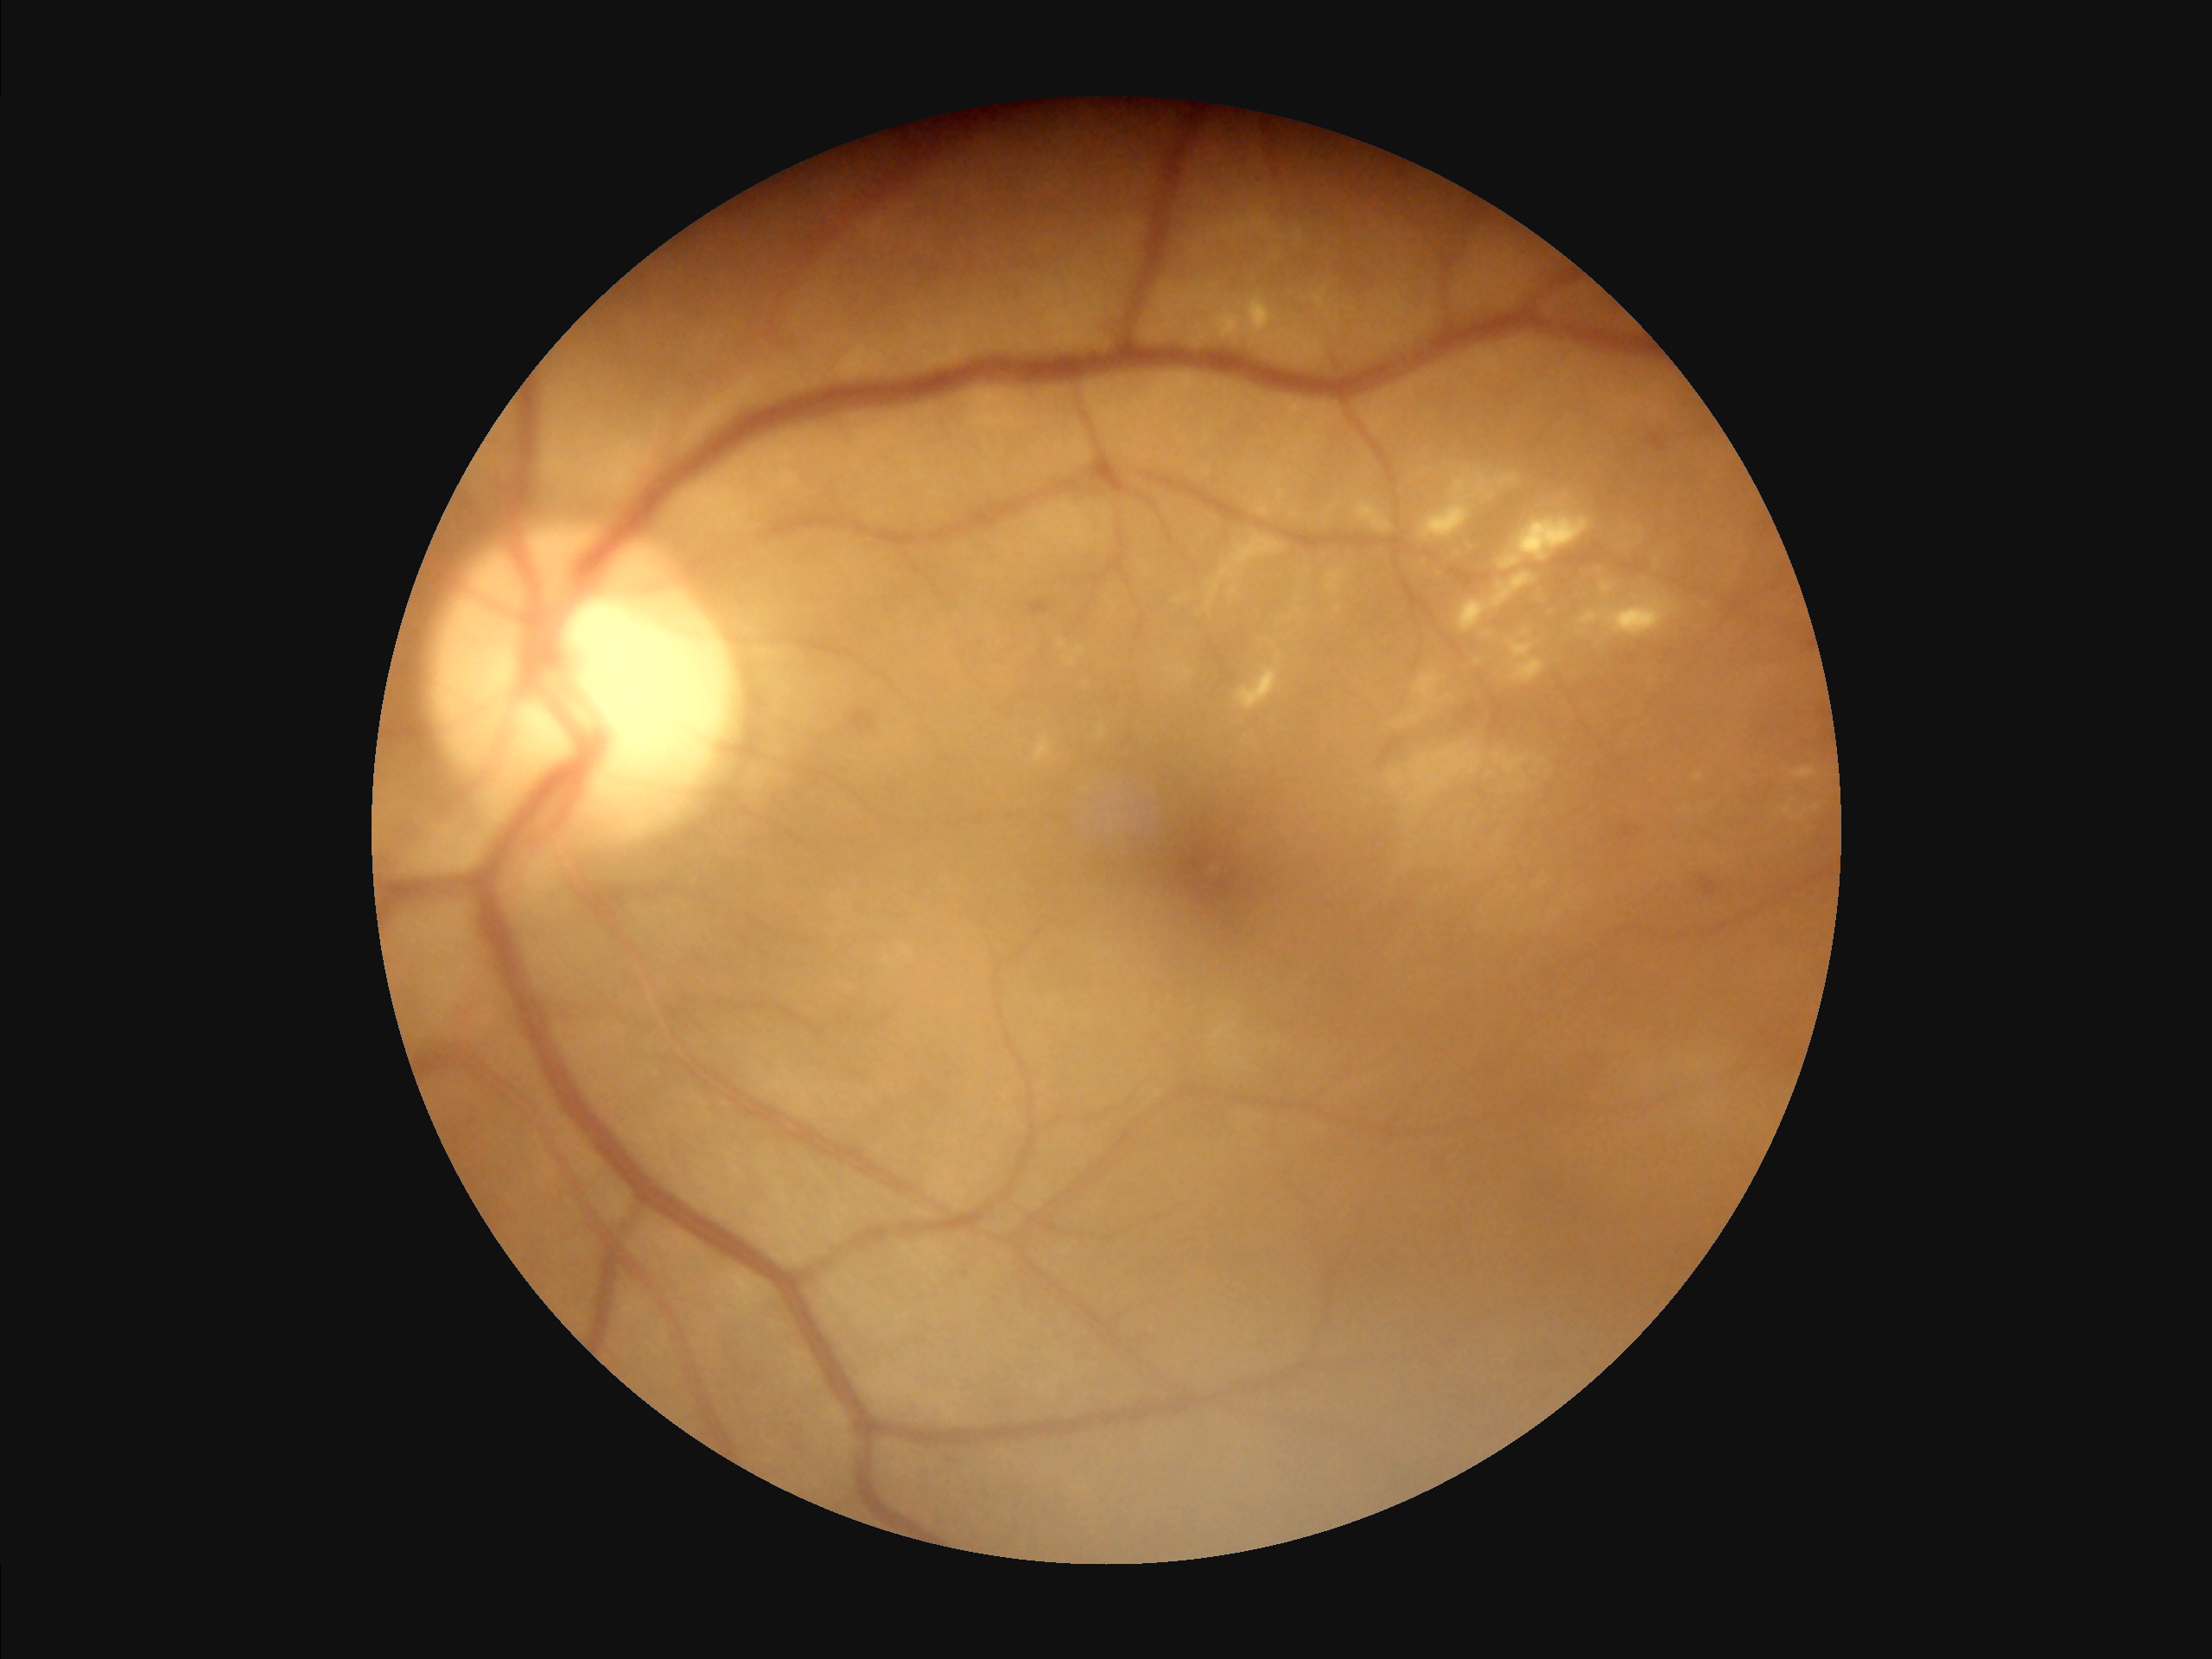
Image quality assessment: illumination: poor | overall: poor.